848 by 848 pixels.
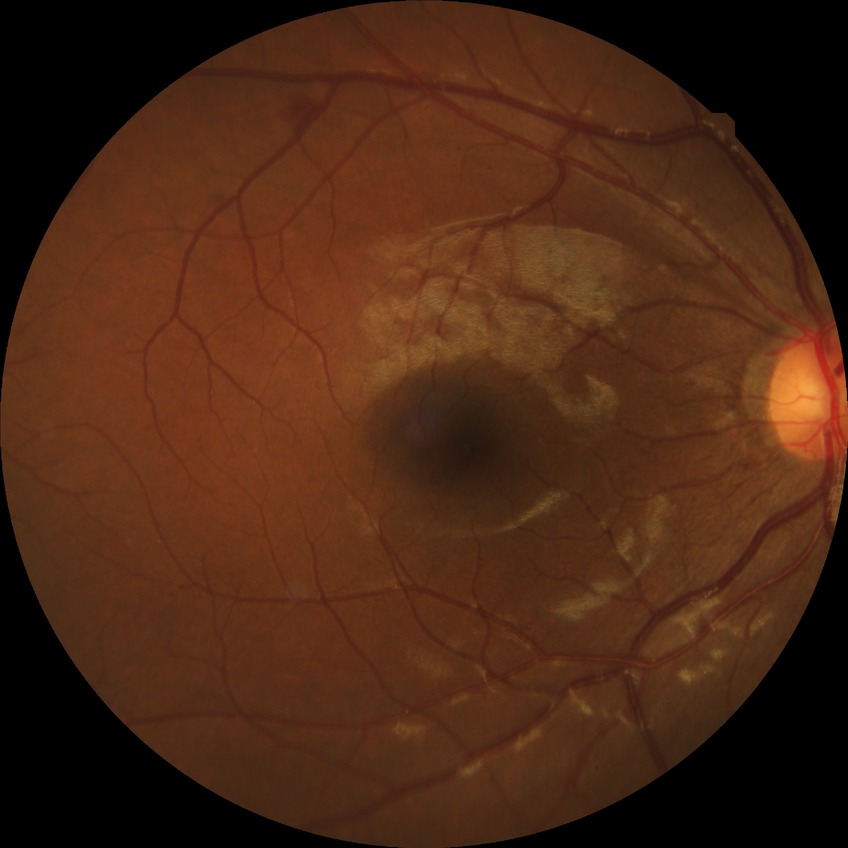
Modified Davis classification is simple diabetic retinopathy.